FOV: 45 degrees. Image size 1932x1910:
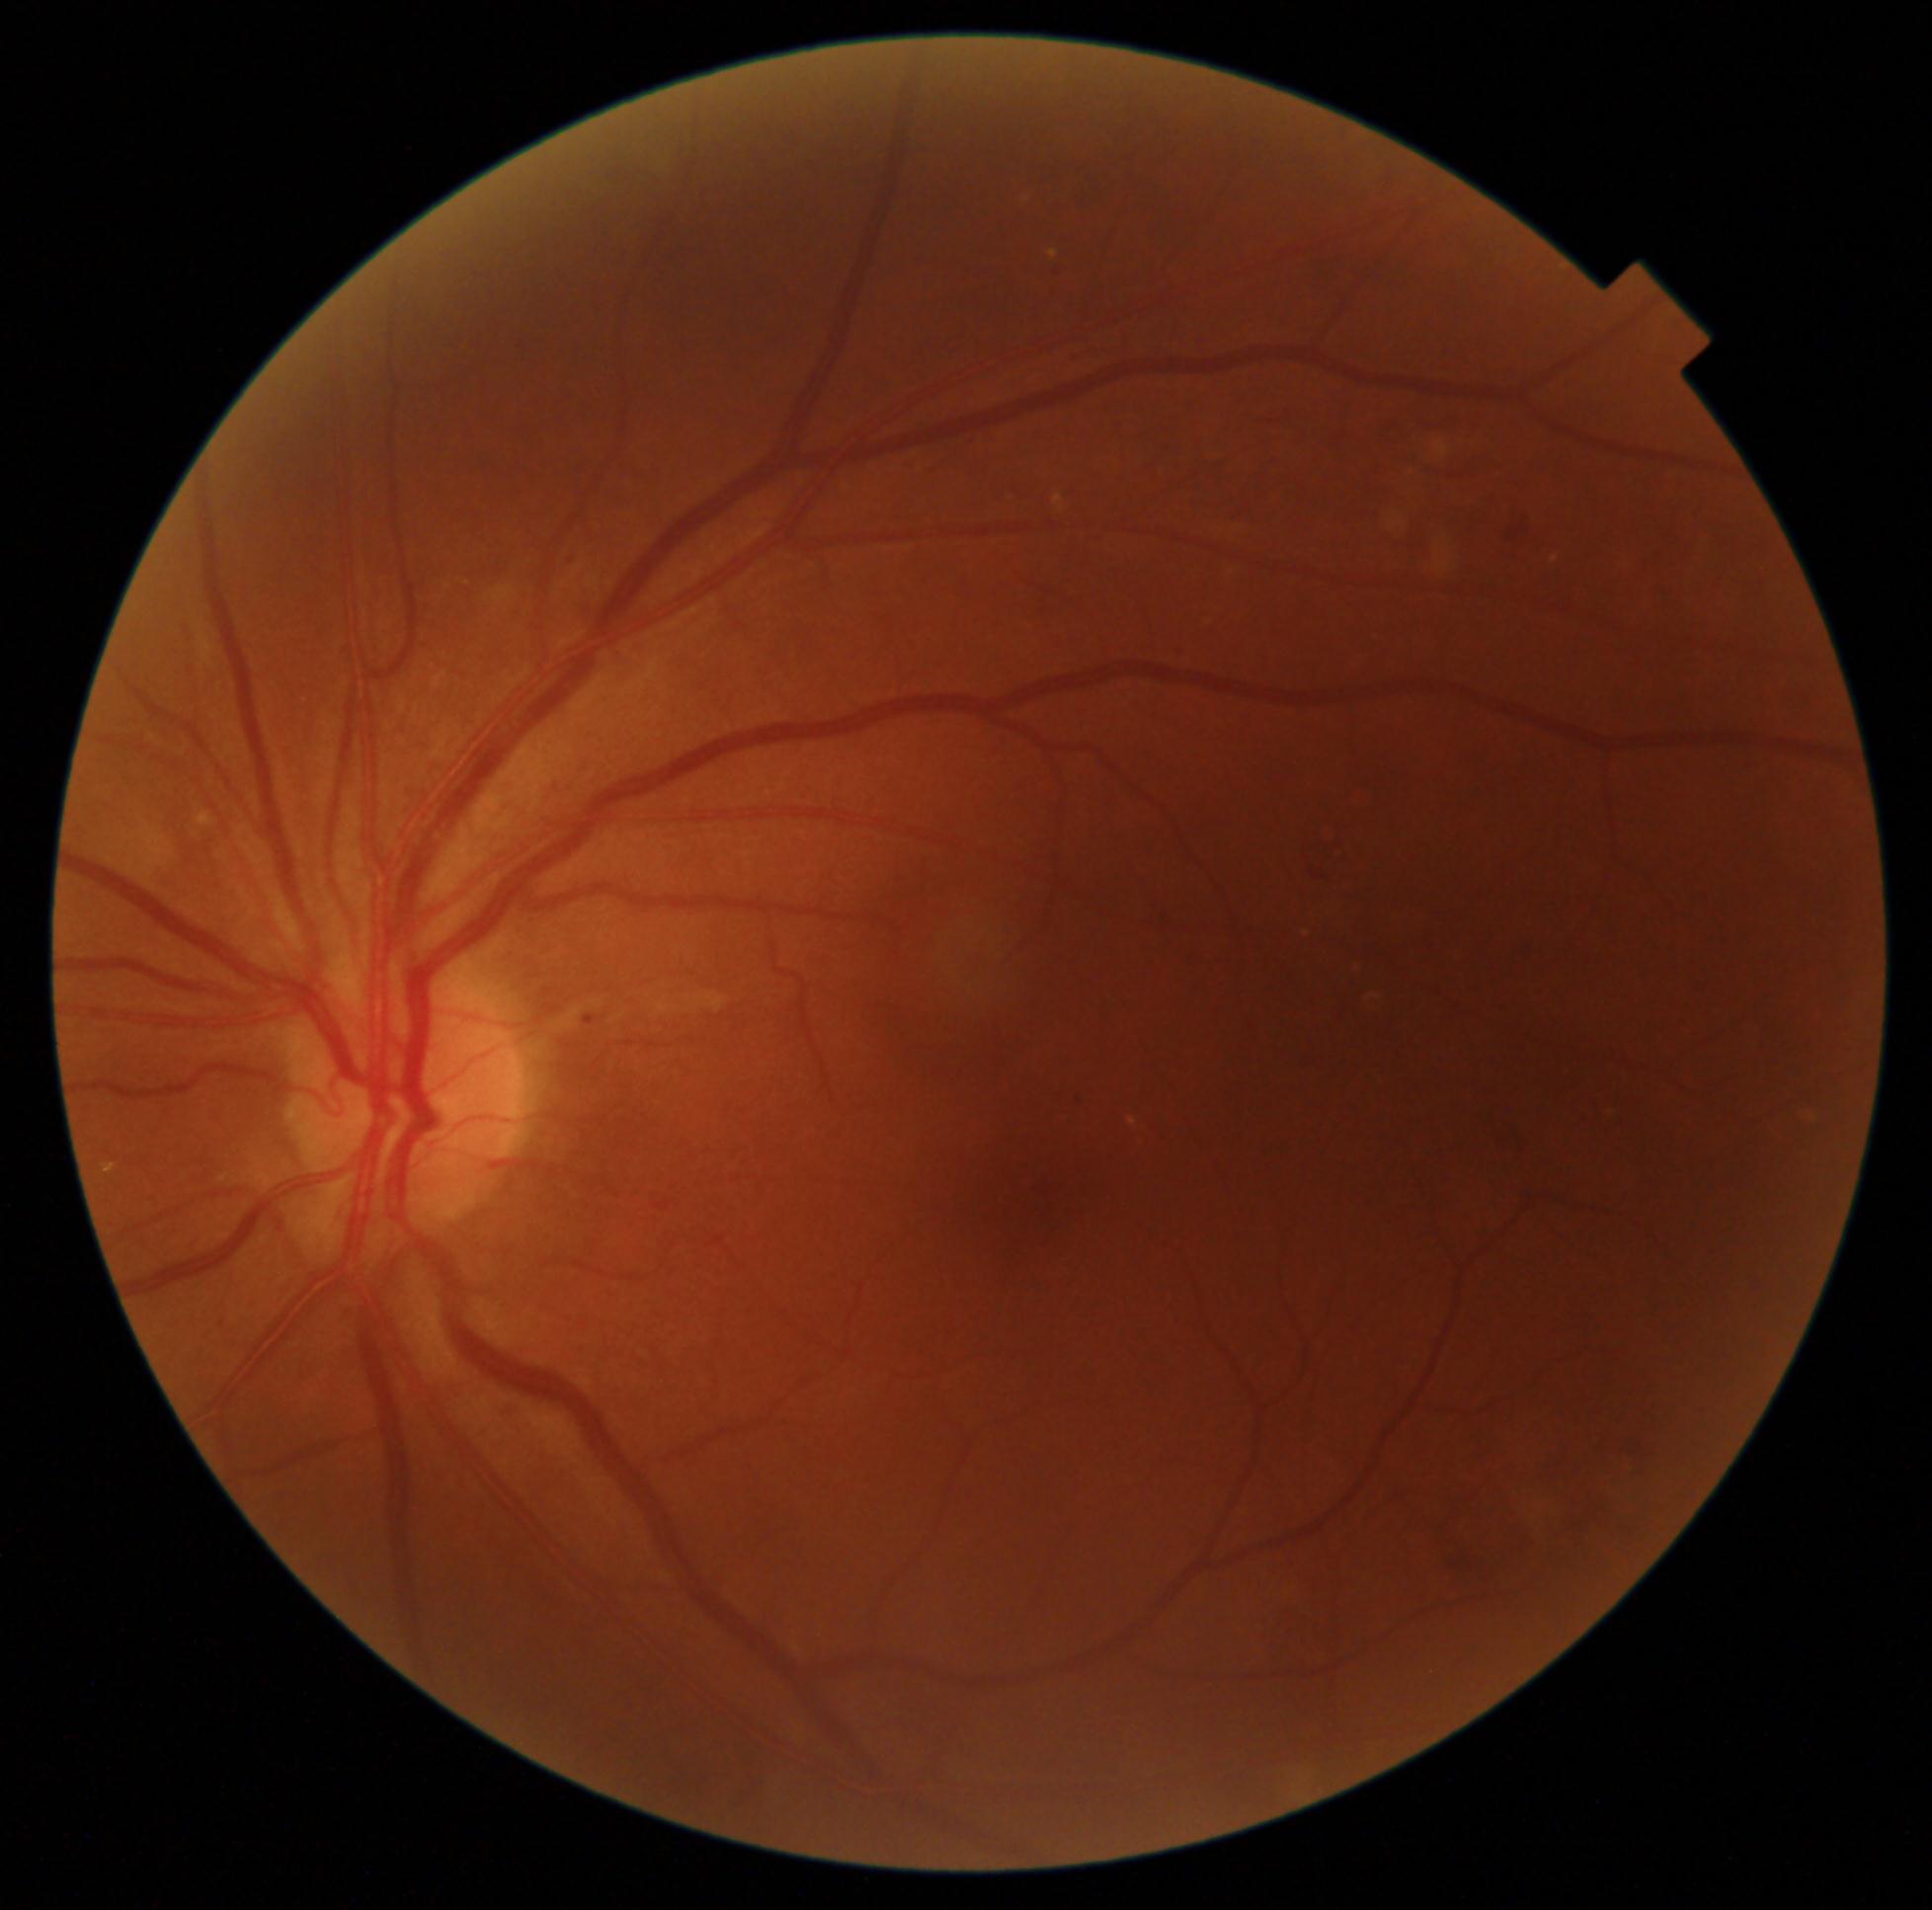

Annotations:
- DR class: non-proliferative diabetic retinopathy
- diabetic retinopathy (DR): 2/4